CFP: 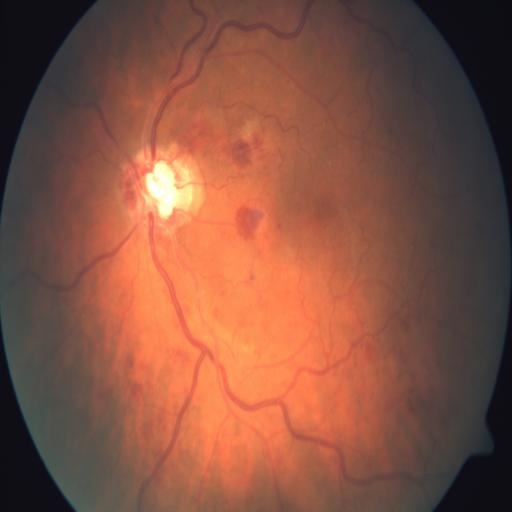 Findings consistent with CRVO (central retinal vein occlusion).